Graded on the modified Davis scale.
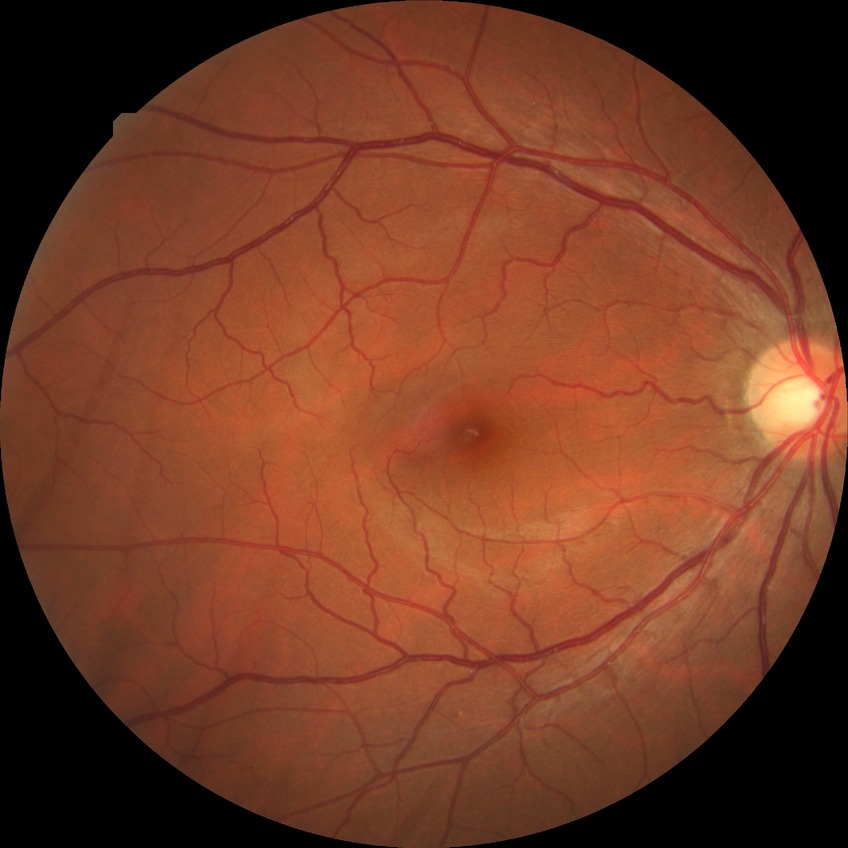
Findings:
* retinopathy stage: no diabetic retinopathy